NIDEK AFC-230 fundus camera
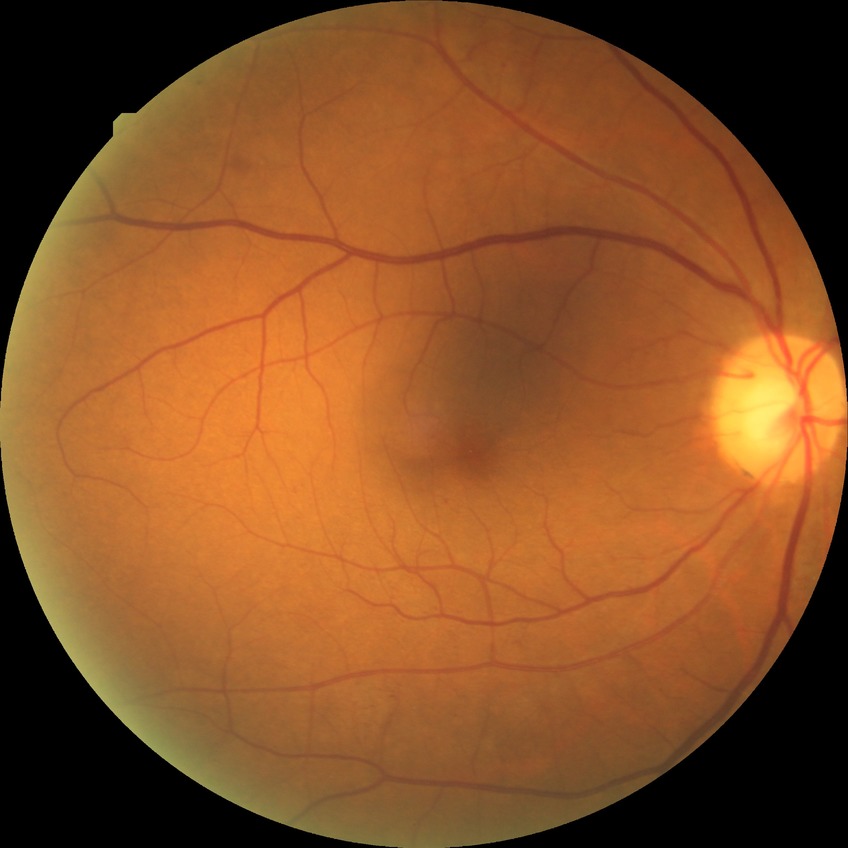
Diabetic retinopathy severity is simple diabetic retinopathy.